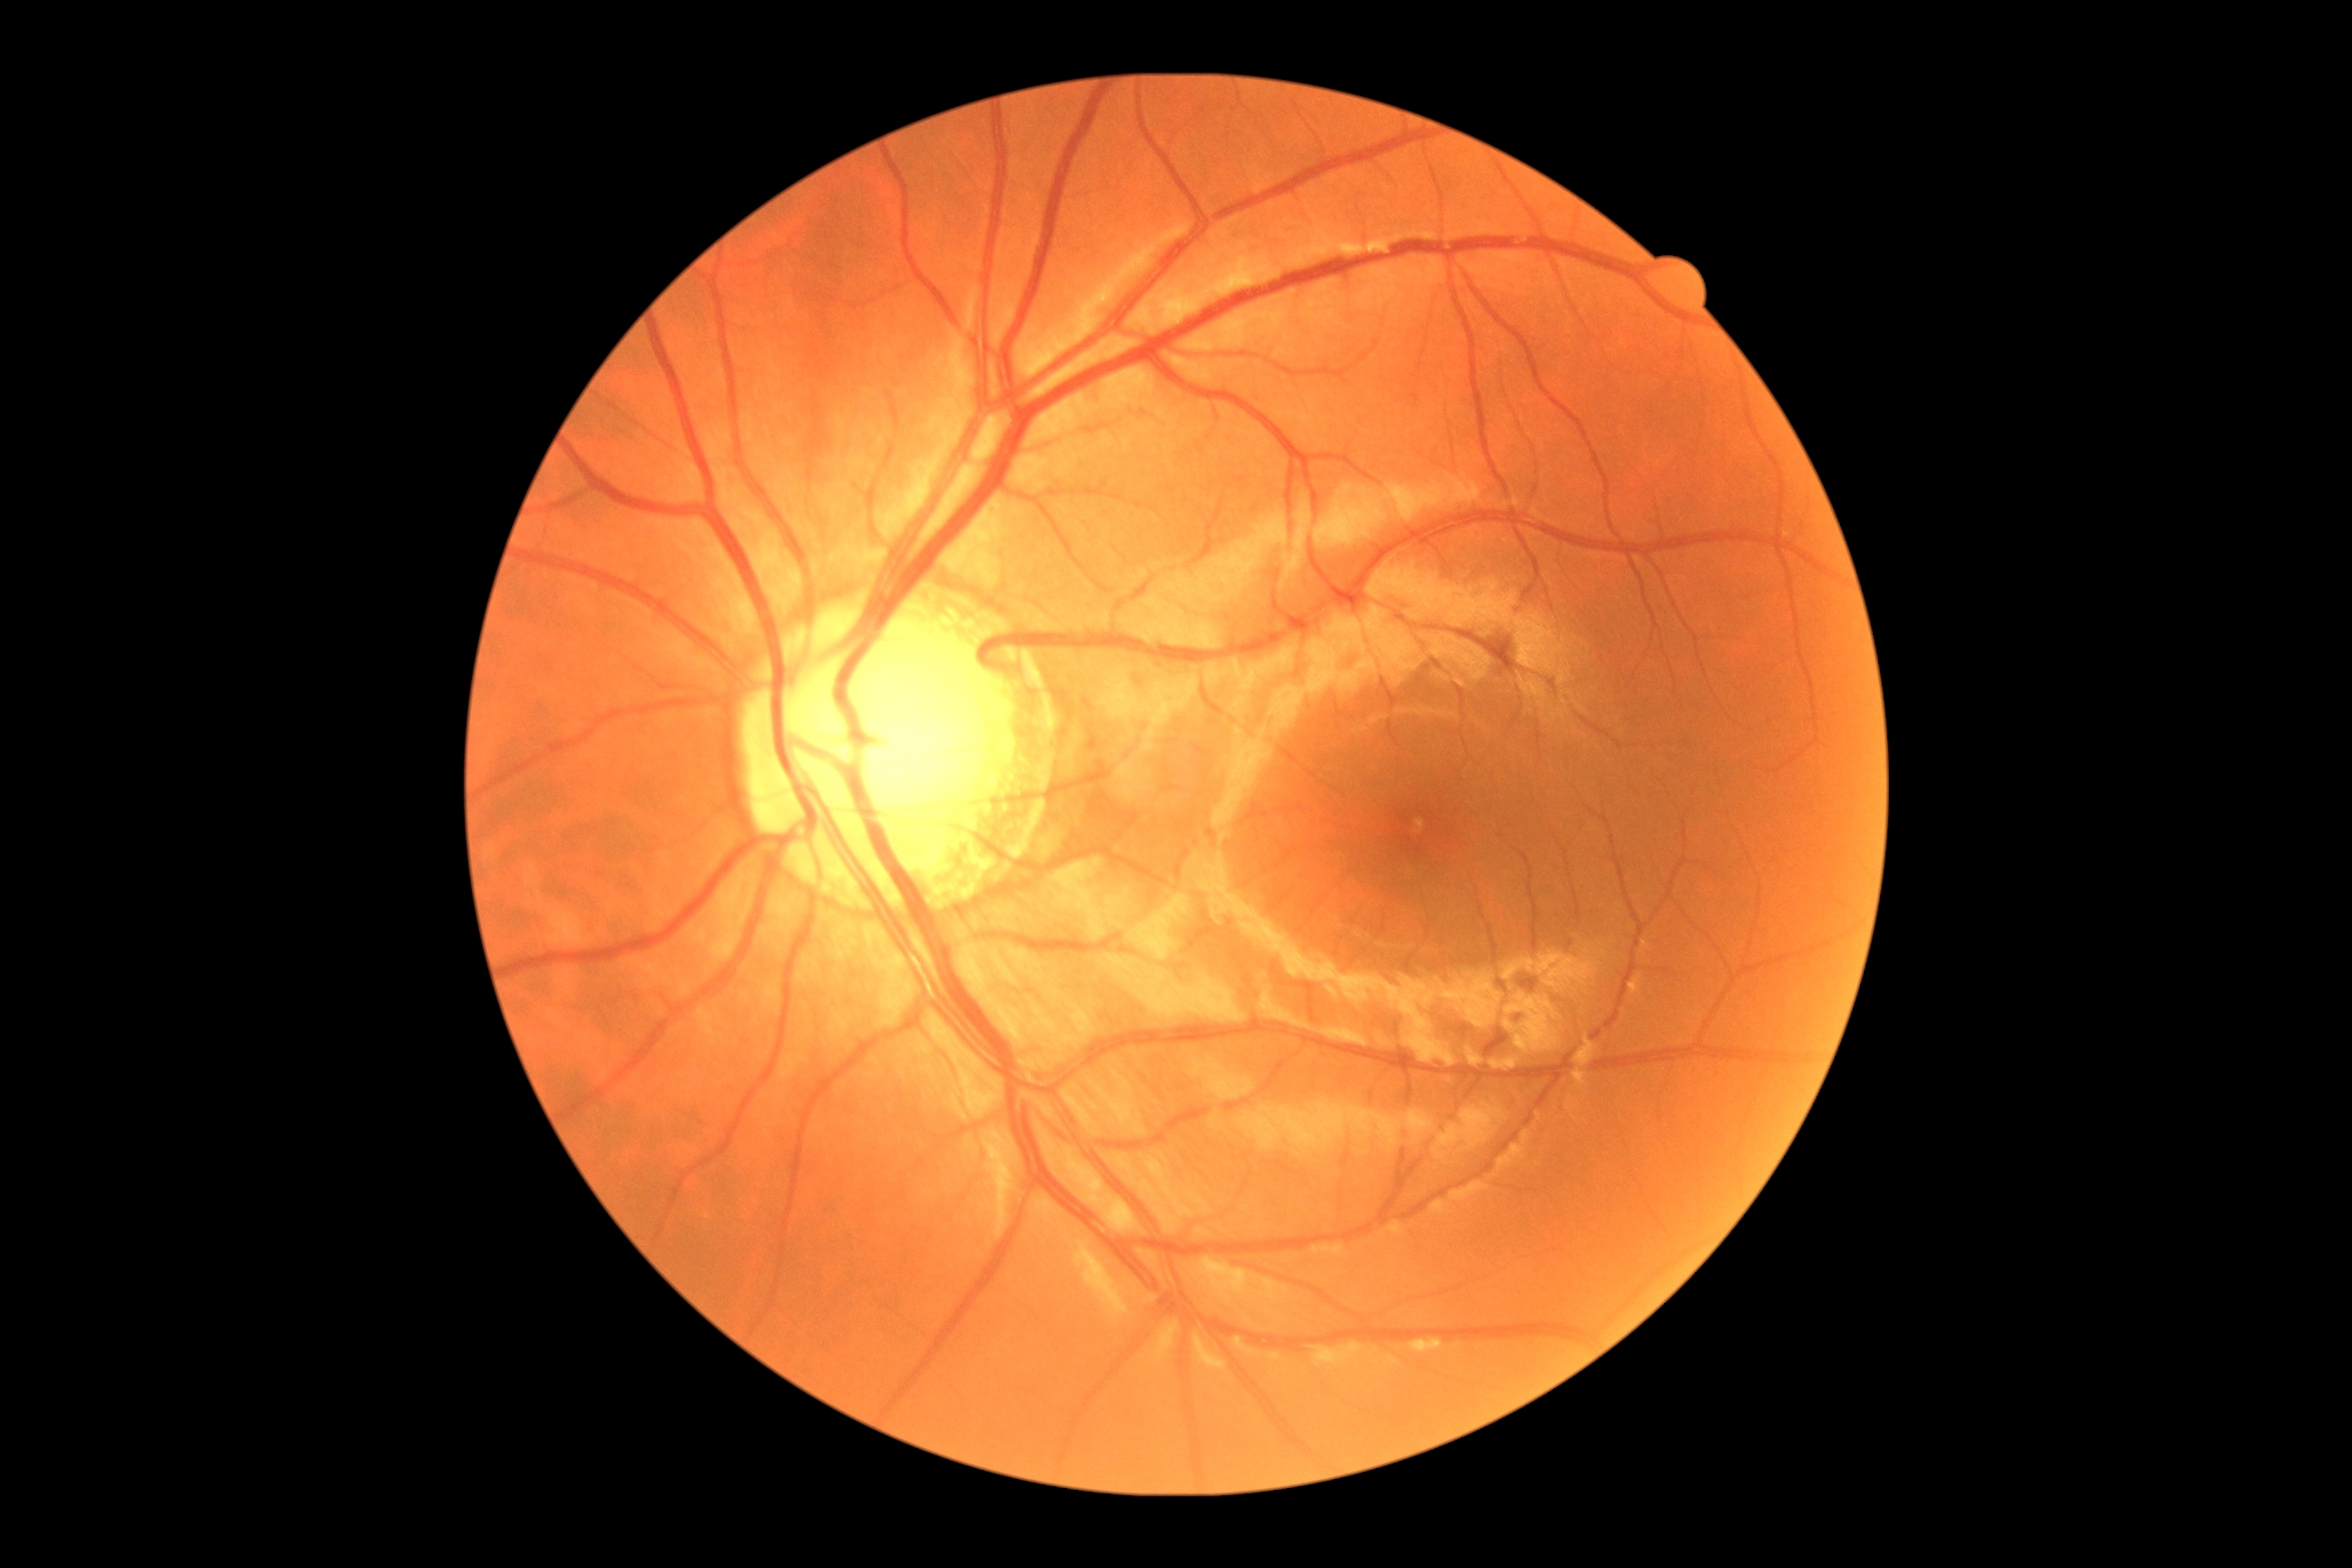
DR severity is no apparent retinopathy (grade 0).